Retinal fundus photograph:
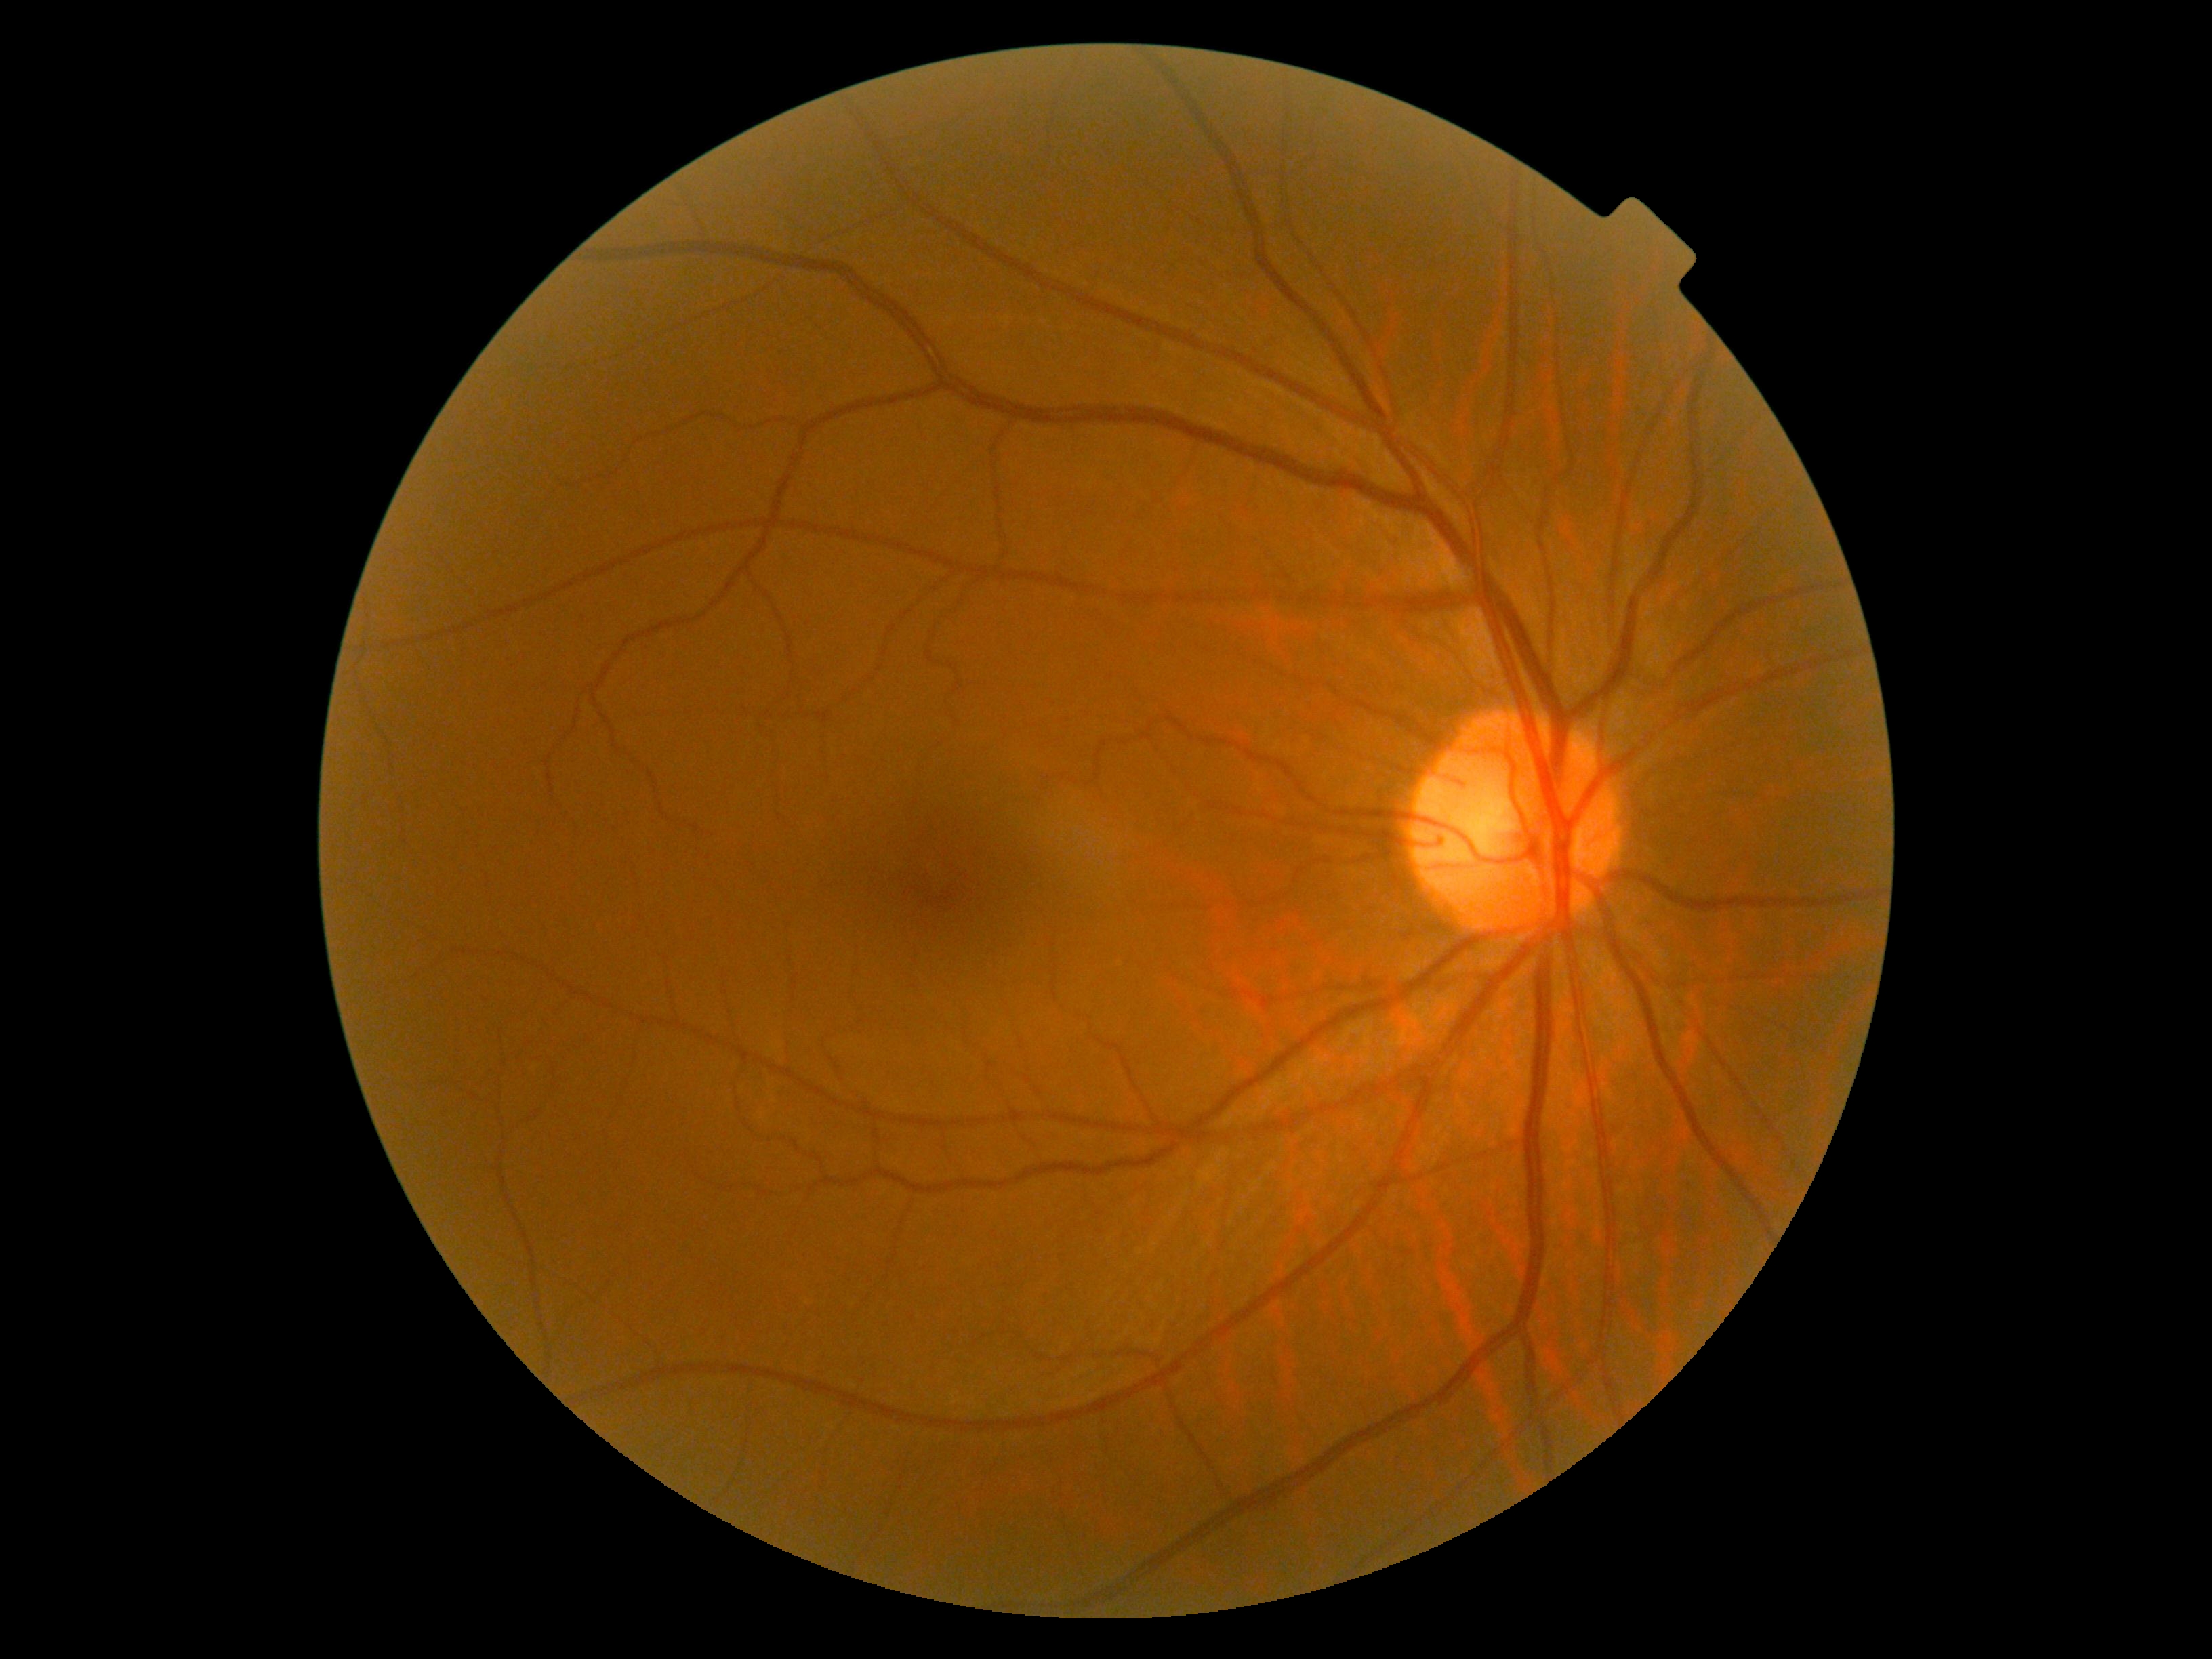

No signs of diabetic retinopathy. DR: no apparent diabetic retinopathy (grade 0).